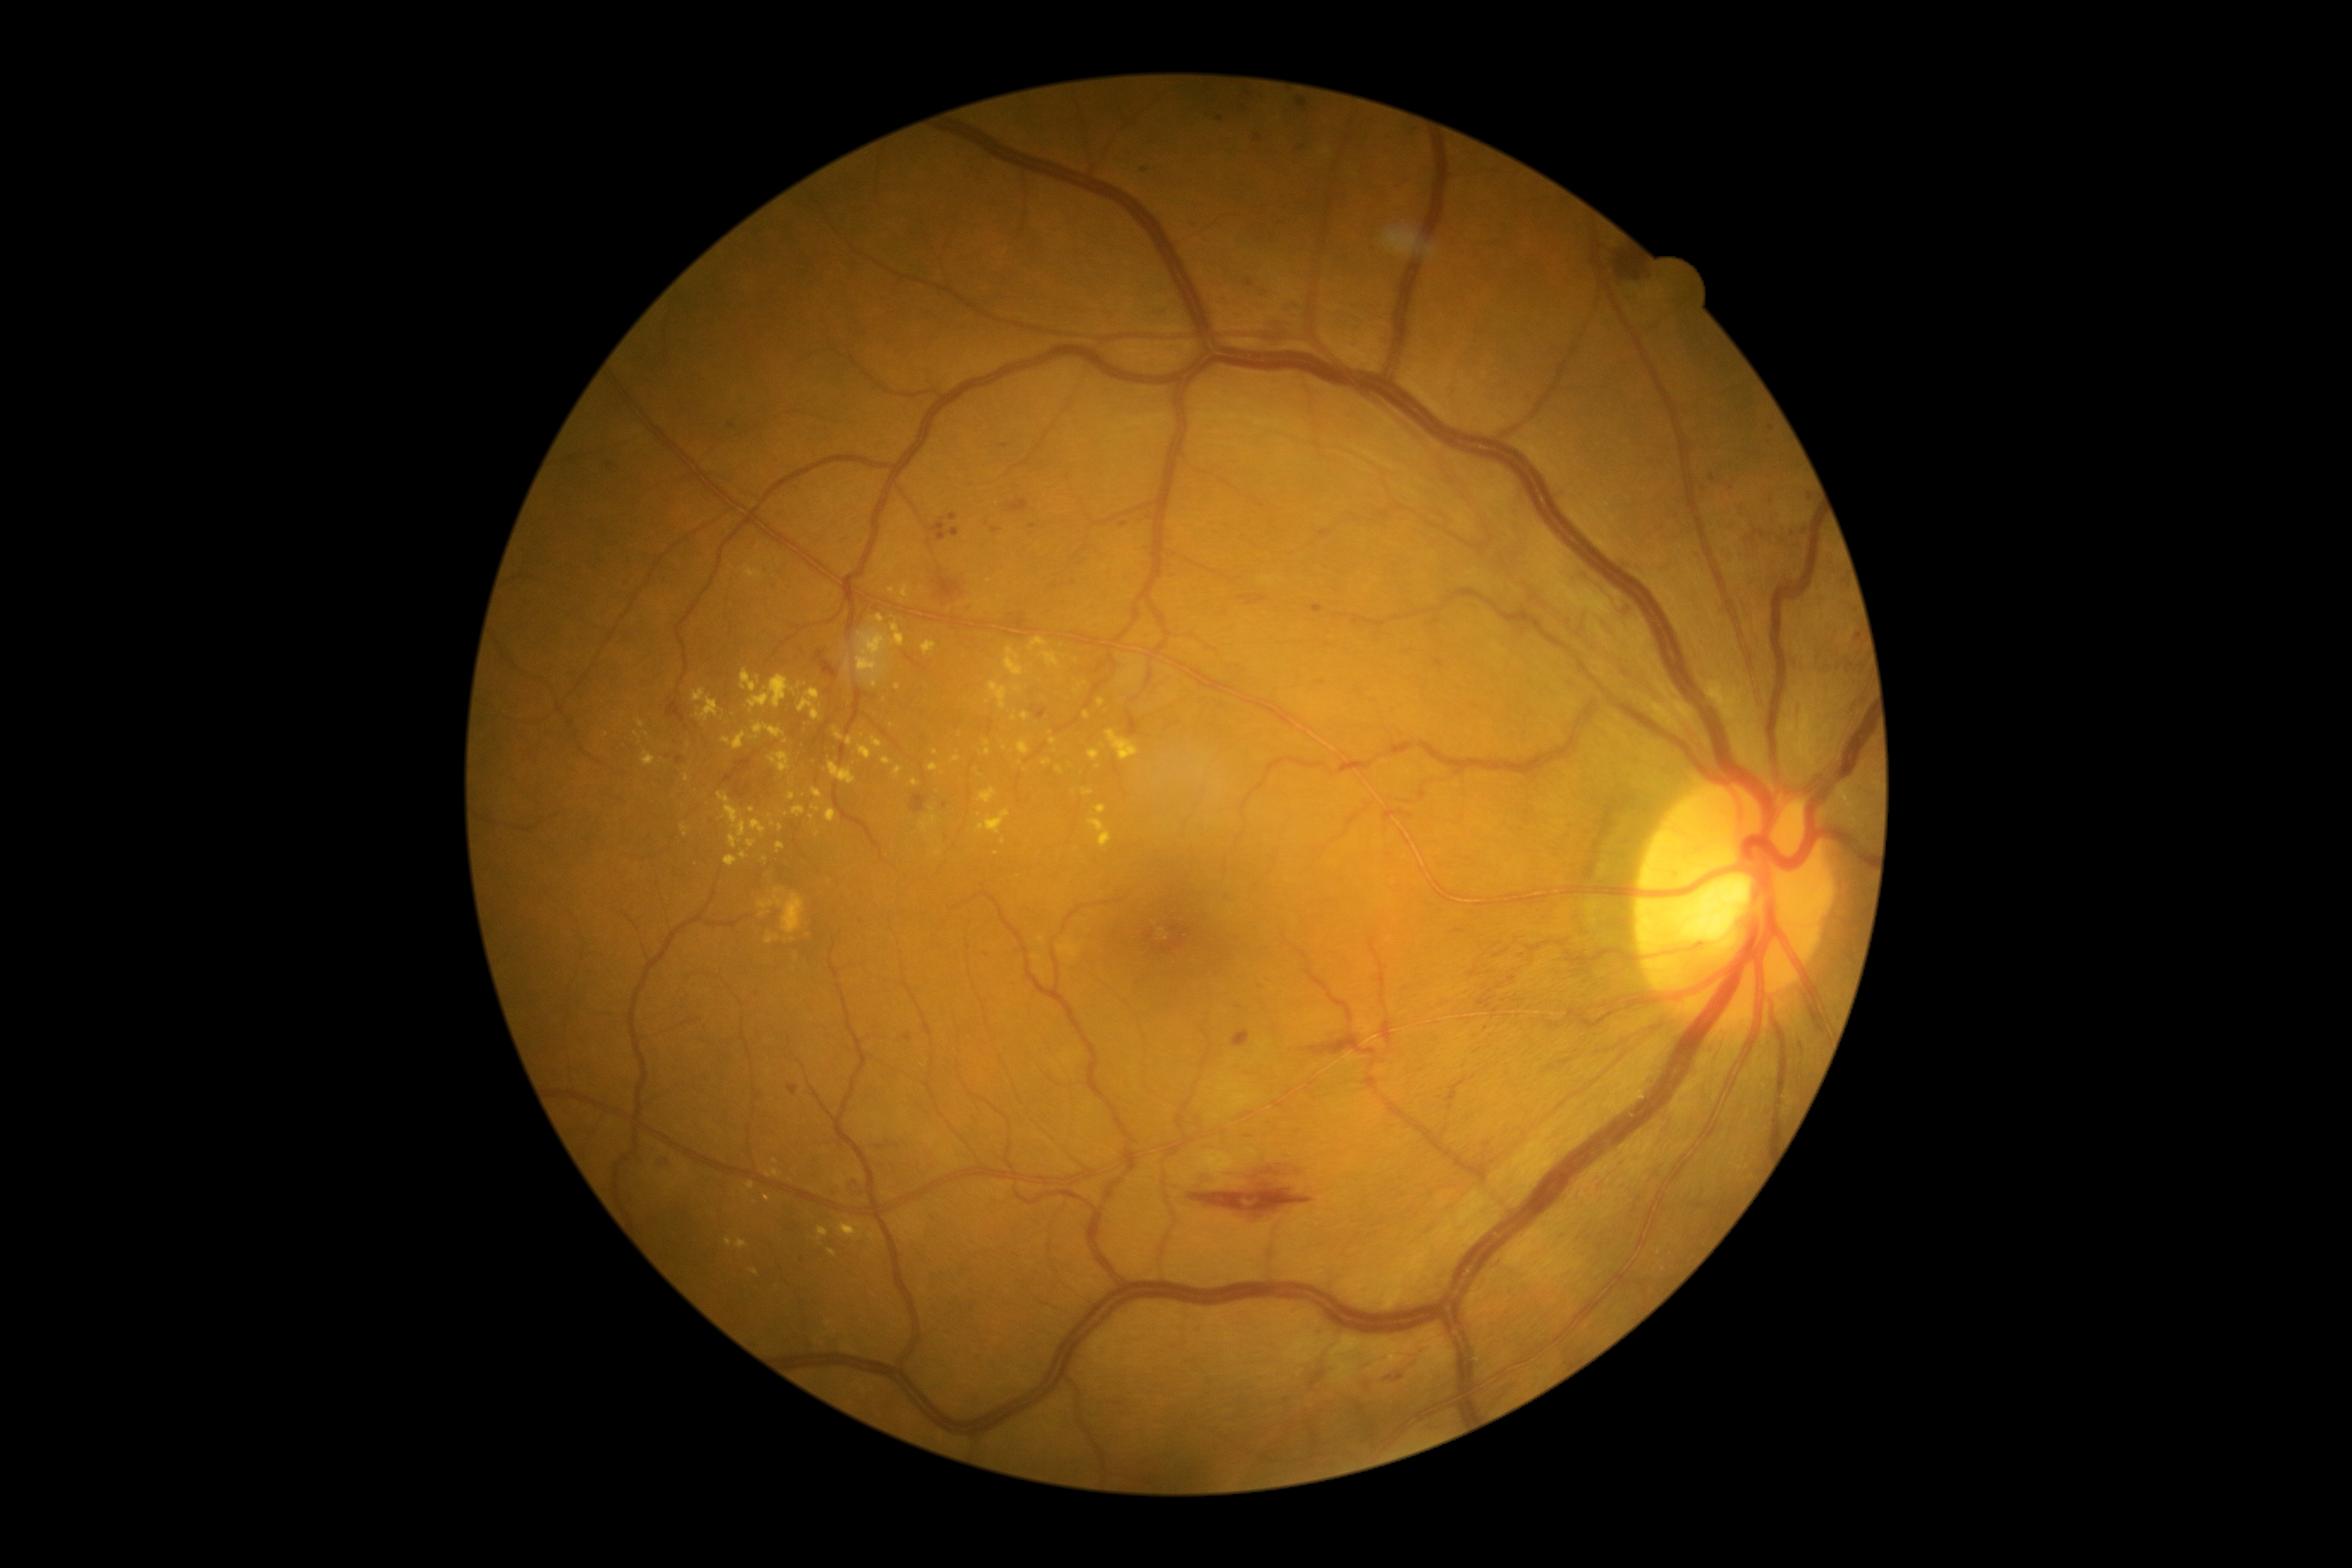

partial: true
dr_grade: 2
dr_grade_name: moderate NPDR
lesions:
  ex:
    - (818,1227,830,1239)
    - (950,756,962,764)
    - (764,933,780,945)
    - (740,670,761,694)
    - (799,689,821,721)
    - (1058,945,1081,948)
    - (1098,699,1105,707)
    - (824,585,833,592)
    - (1082,790,1093,797)
    - (749,675,797,713)
    - (812,788,823,799)
    - (750,819,768,836)
  ex_small:
    - 938, 852
    - 1053, 741
    - 773, 824
    - 688, 745
    - 752, 809
    - 1005, 748
    - 1163, 931
    - 936, 753
  ma:
    - (1476,996,1495,1010)
    - (1297,99,1309,111)
    - (1247,279,1254,288)
    - (1246,92,1254,97)
    - (1320,530,1332,539)
    - (1859,665,1865,673)
    - (659,1156,668,1163)
    - (1256,133,1263,144)
    - (1469,967,1483,977)
    - (1435,659,1445,668)
  ma_small:
    - 1488, 1145
    - 1360, 690
    - 1486, 1028
    - 944, 806
    - 1004, 447
    - 1521, 956
    - 1856, 637
    - 1221, 119